Graded on the modified Davis scale
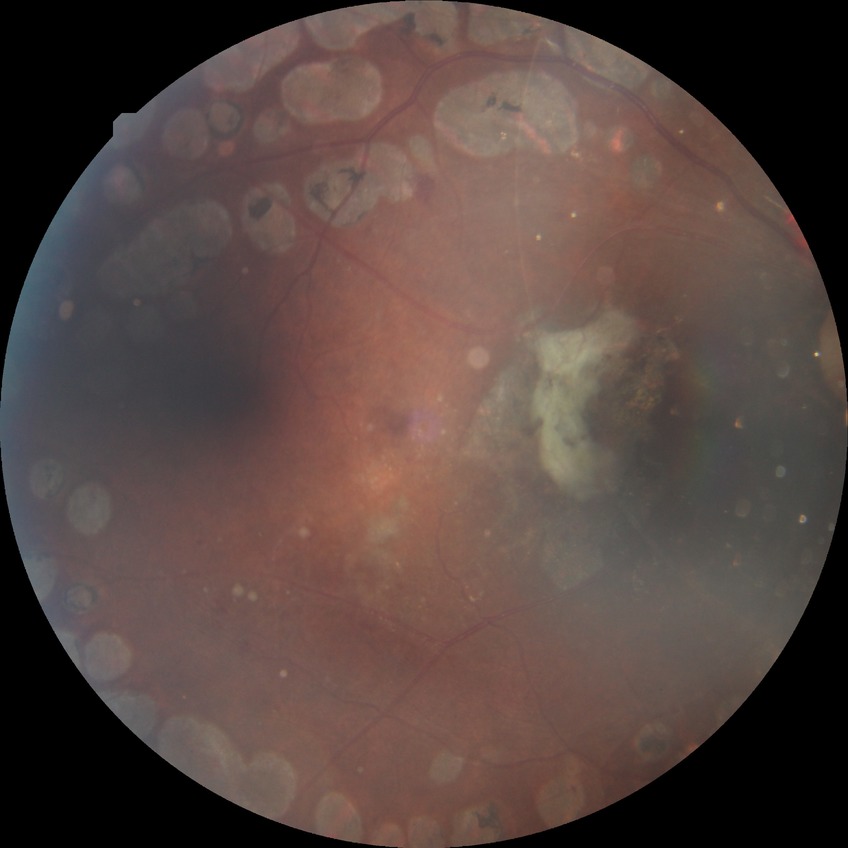

Diabetic retinopathy (DR) is PDR (proliferative diabetic retinopathy).